CFP · mydriatic (tropicamide phenylephrine 1.0%): 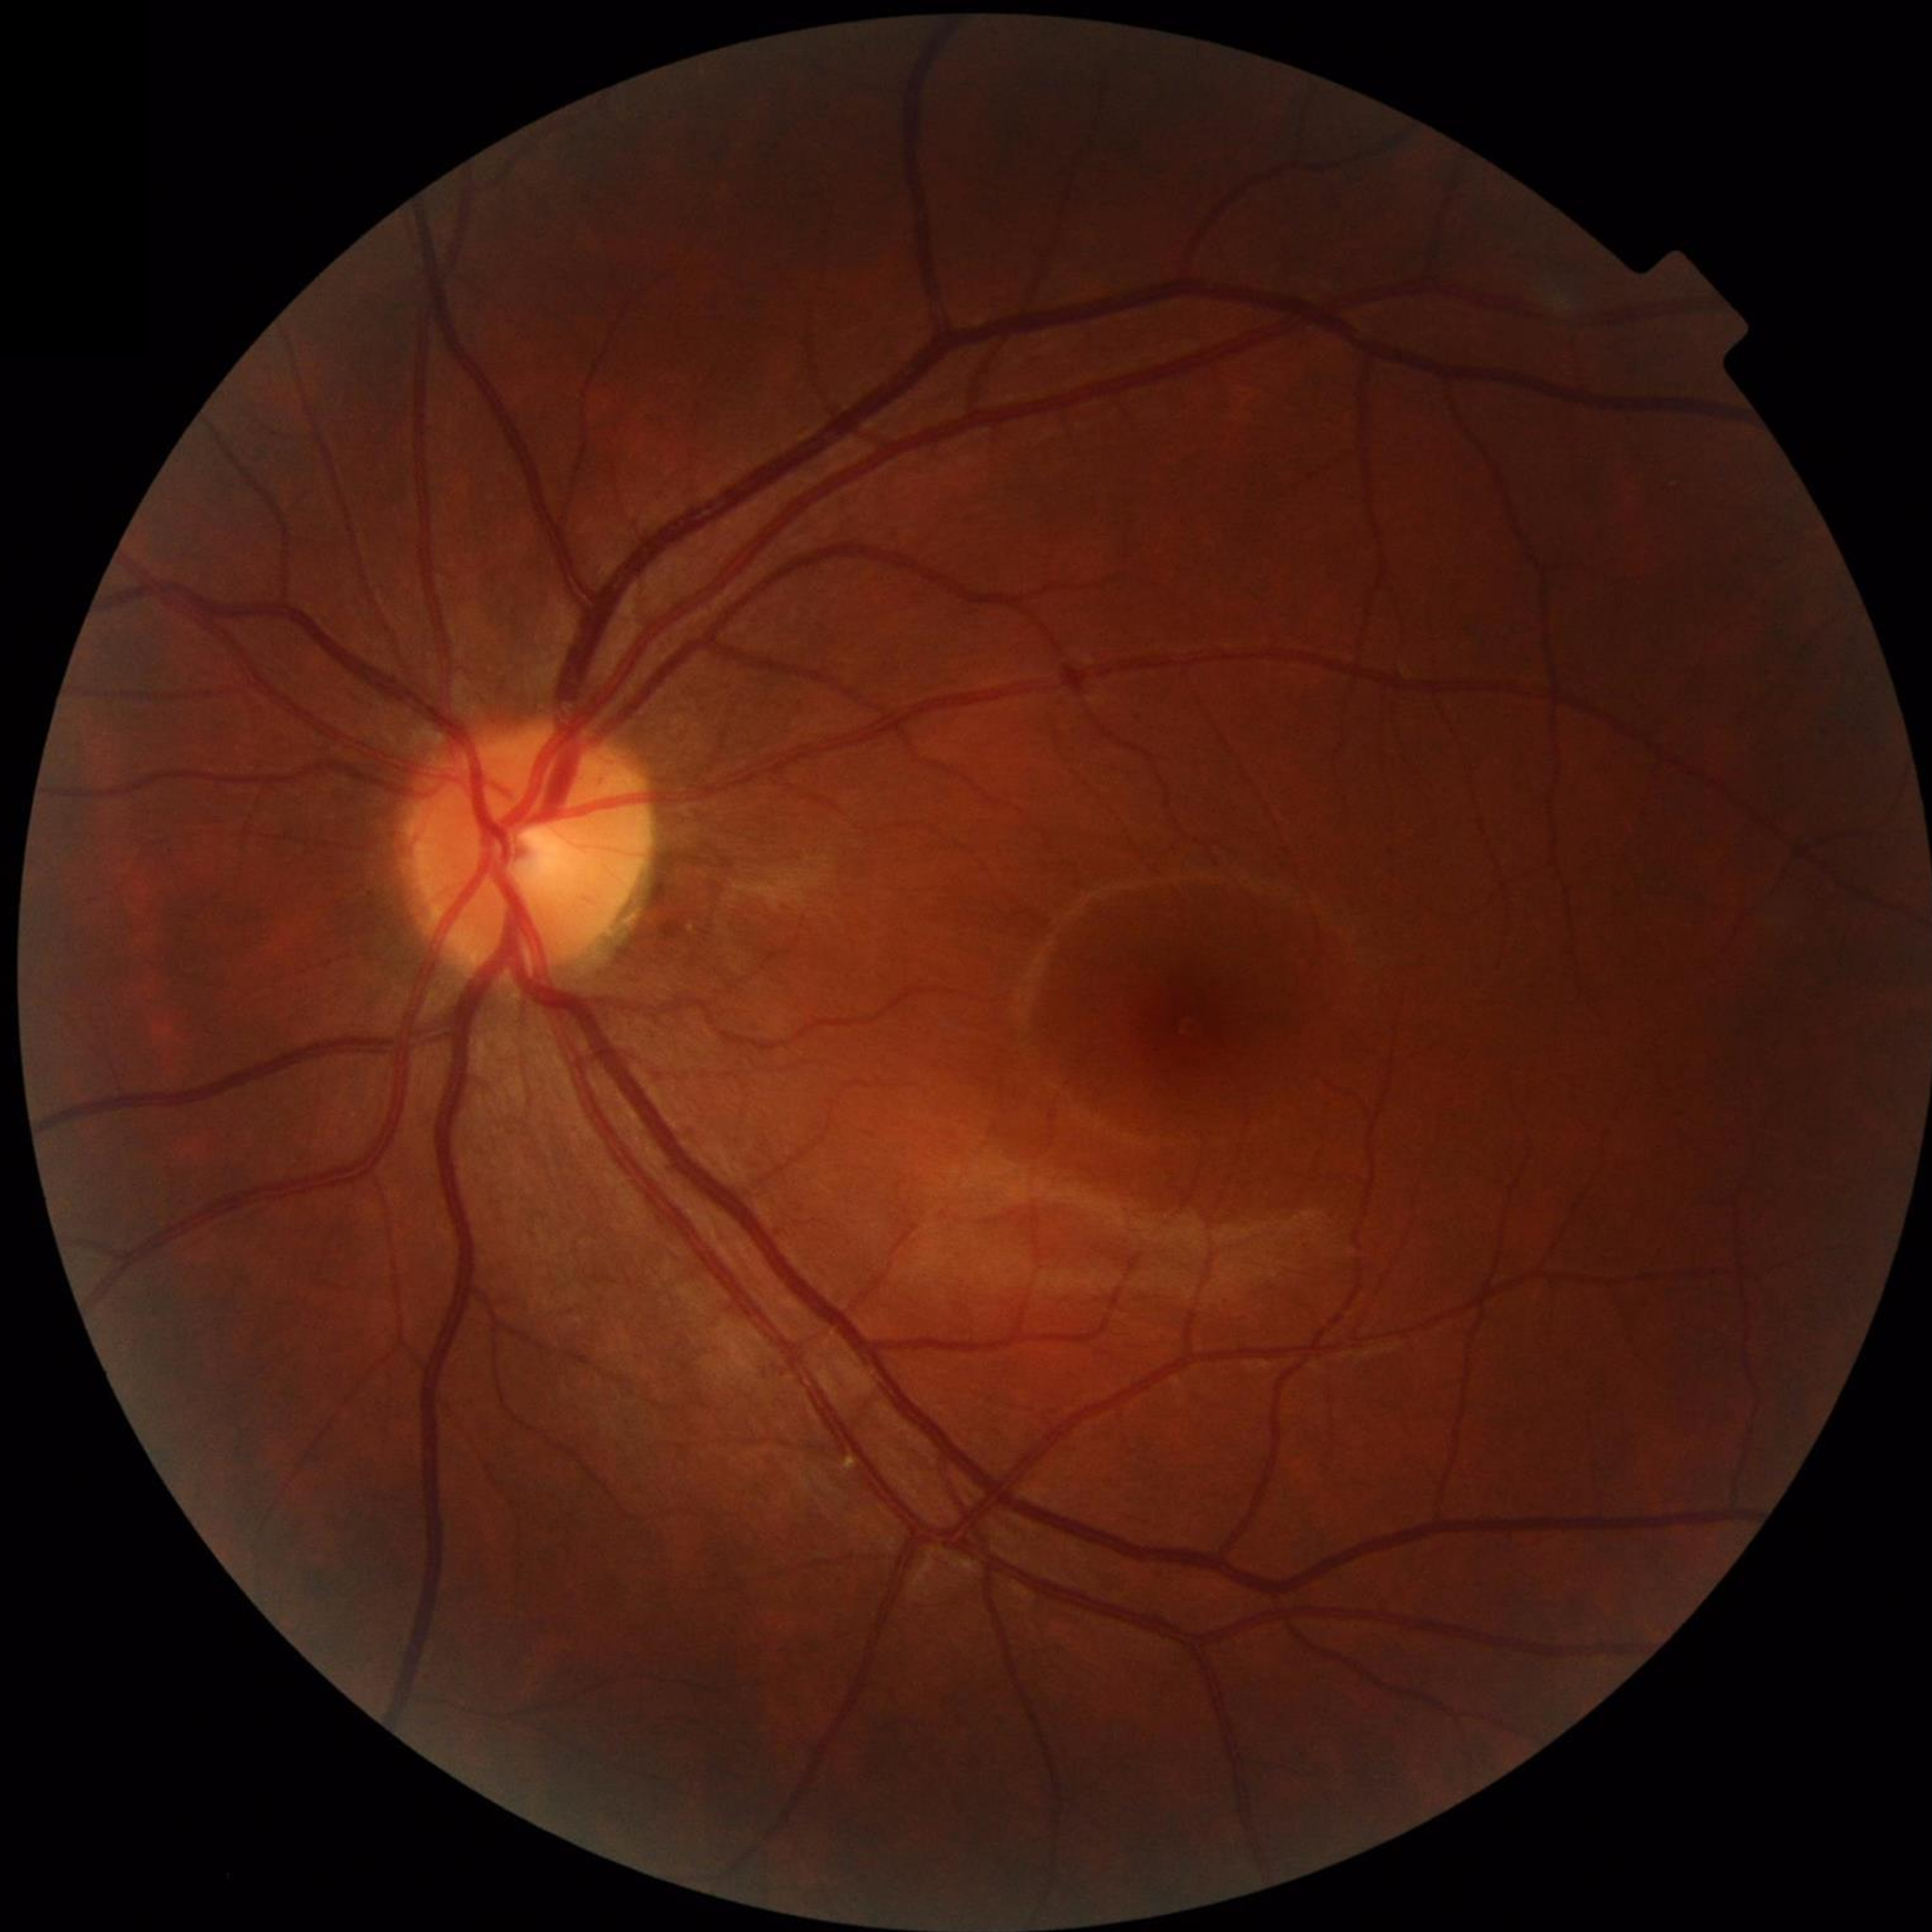 Quality assessment: no blur, contrast adequate, illumination and color satisfactory.
No signs of AMD, diabetic retinopathy, or glaucoma.